Dilated-pupil acquisition; 2228 x 1652 pixels.
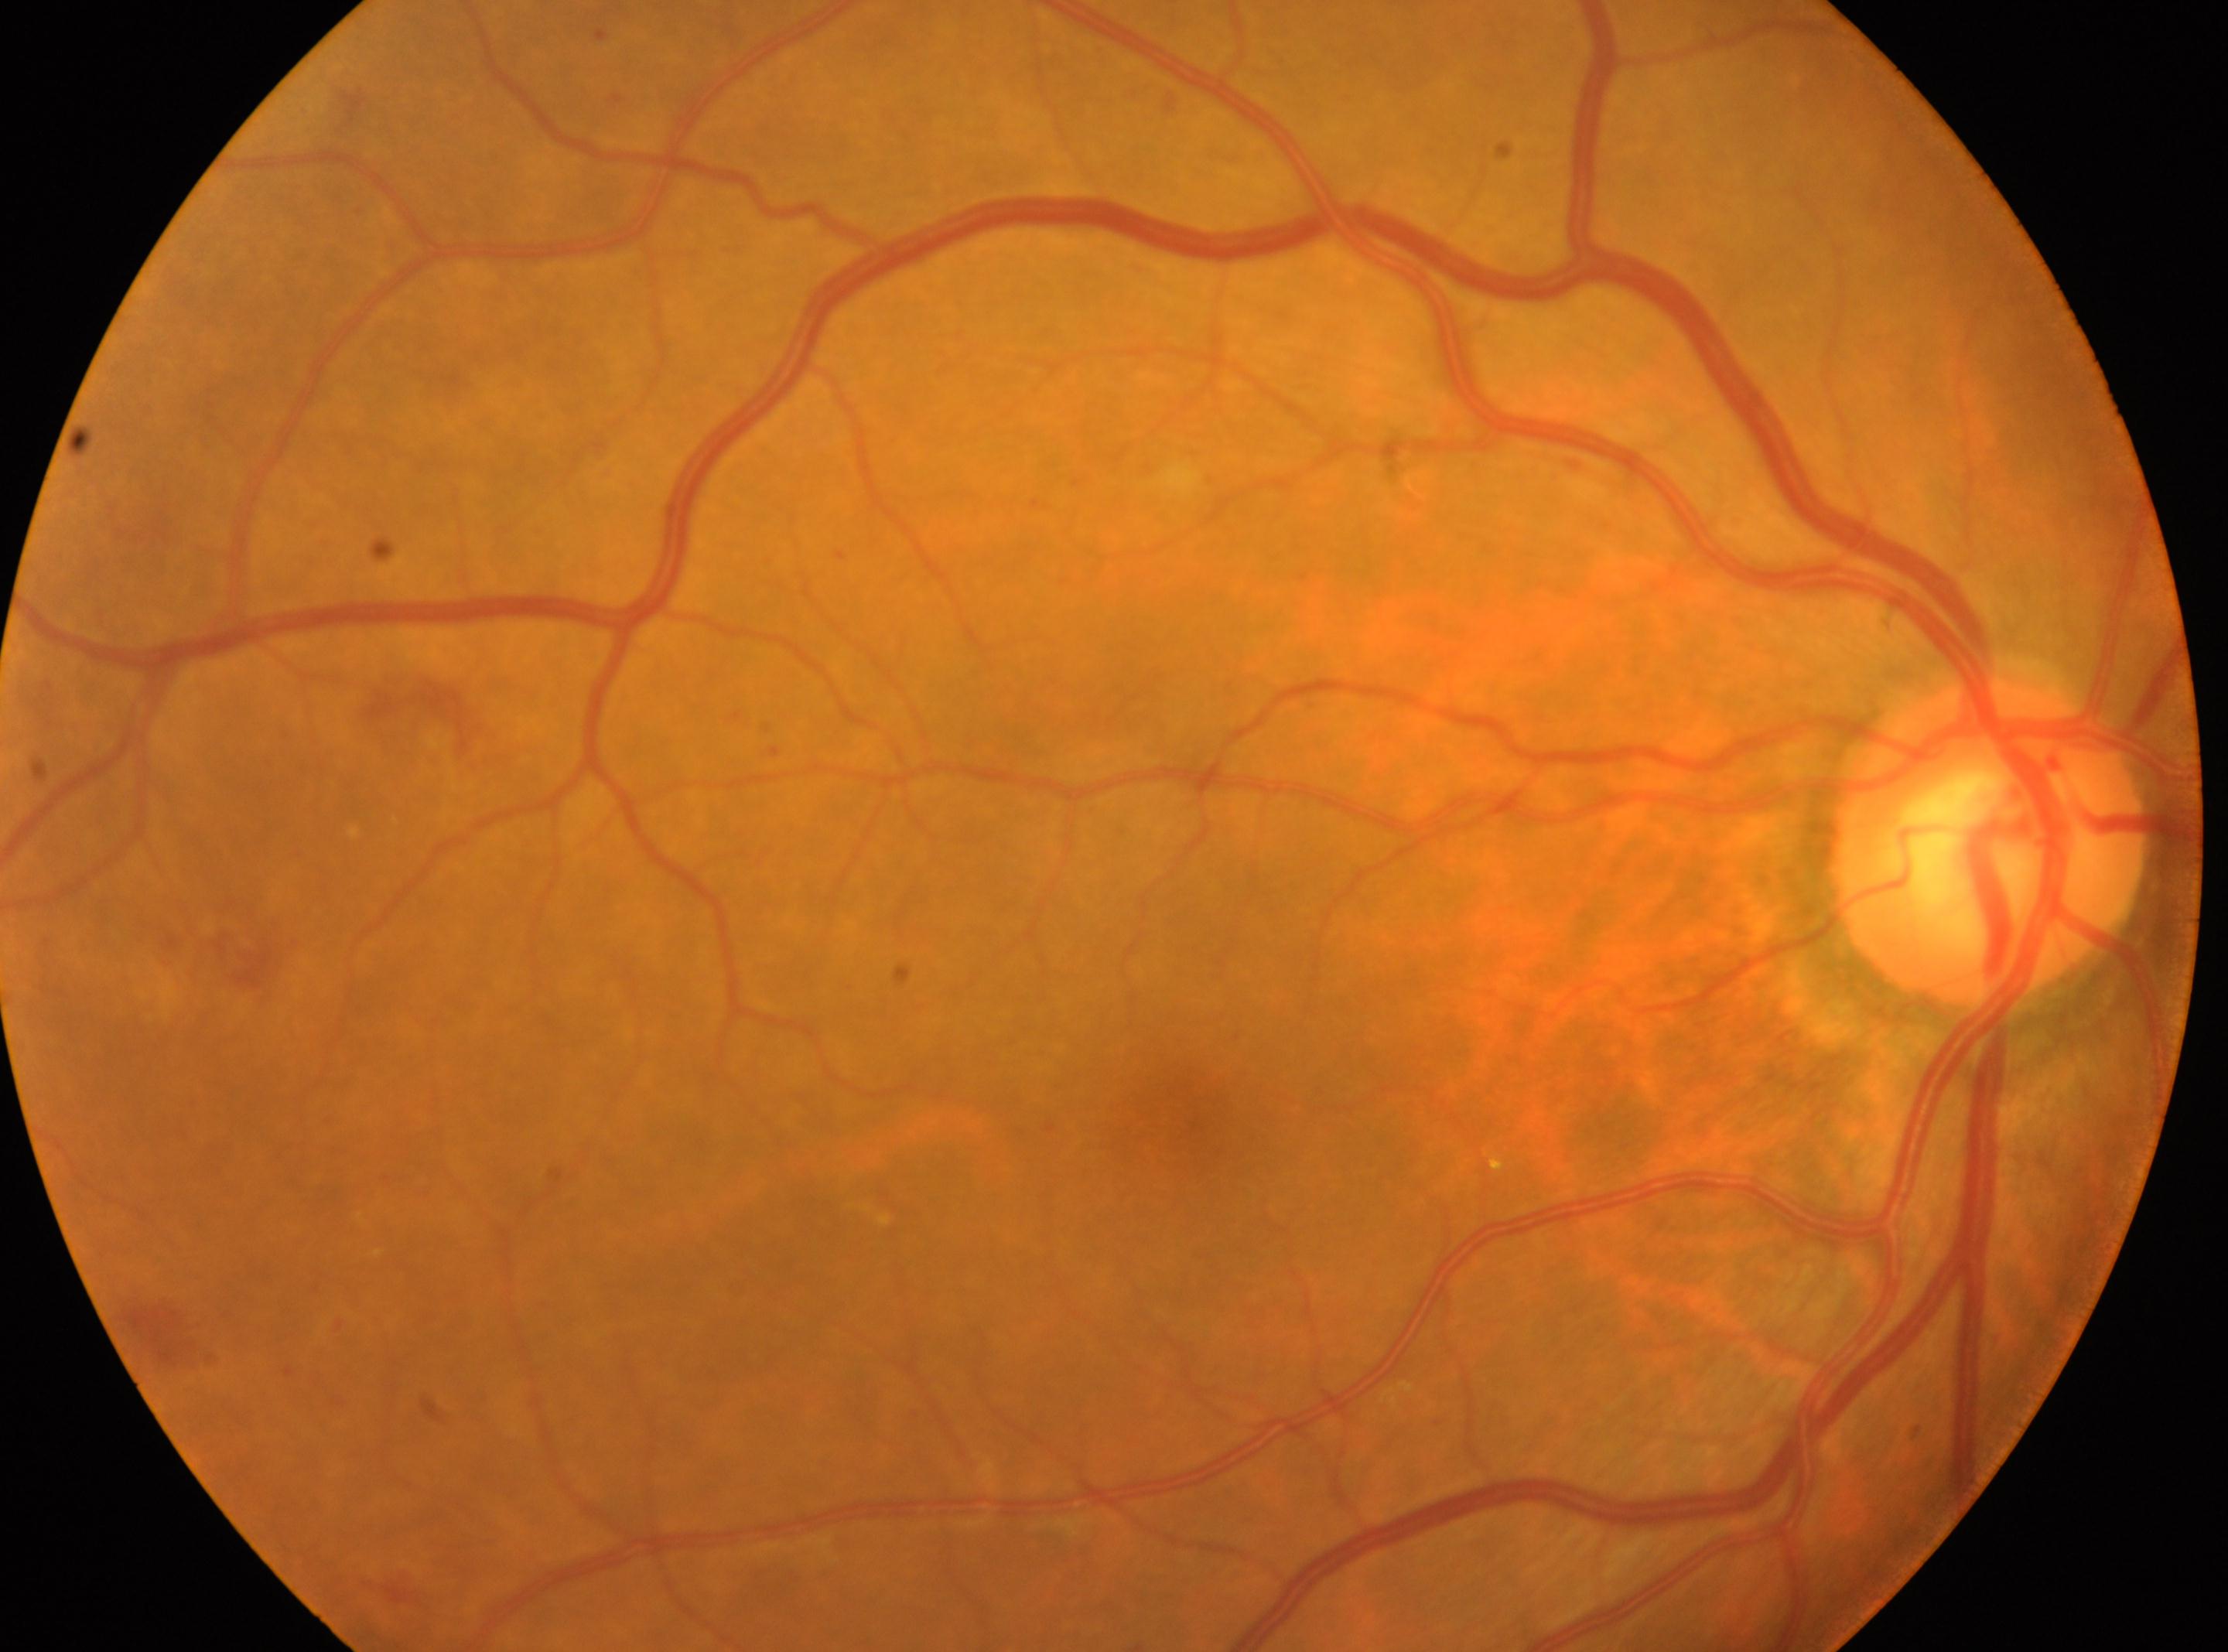
| key | value |
|---|---|
| DR class | non-proliferative diabetic retinopathy |
| the fovea | (x=1184, y=1115) |
| the optic disc | (x=1988, y=841) |
| laterality | oculus dexter |
| diabetic retinopathy (DR) | moderate non-proliferative diabetic retinopathy (grade 2) |